848 x 848 pixels; posterior pole photograph: 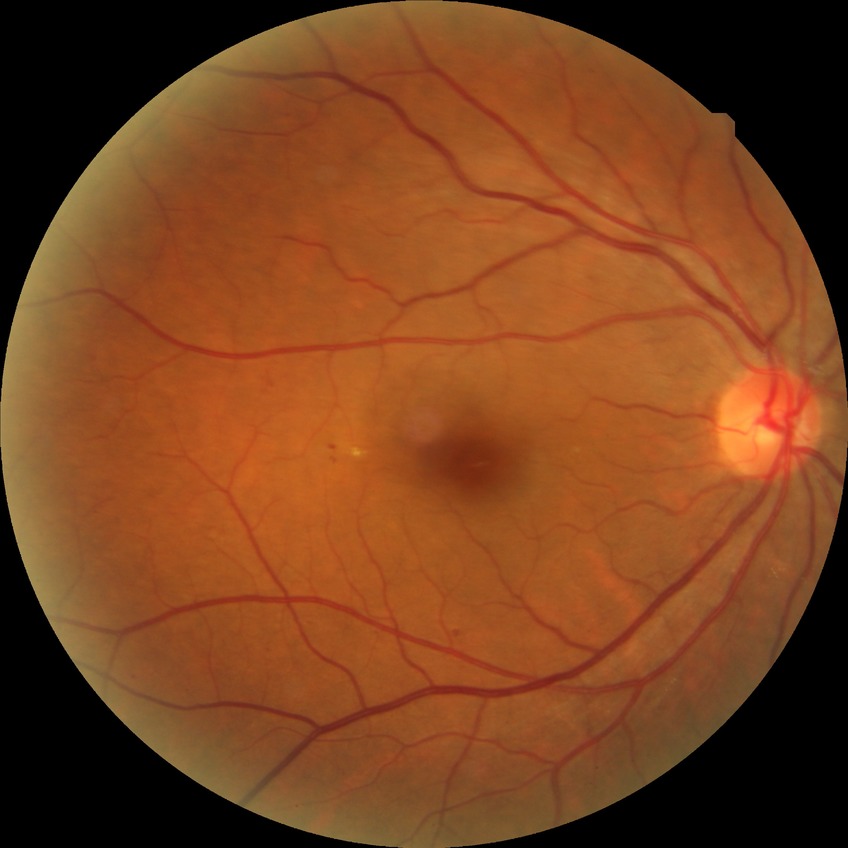

Modified Davis classification: simple diabetic retinopathy.